640x480. Pediatric wide-field fundus photograph — 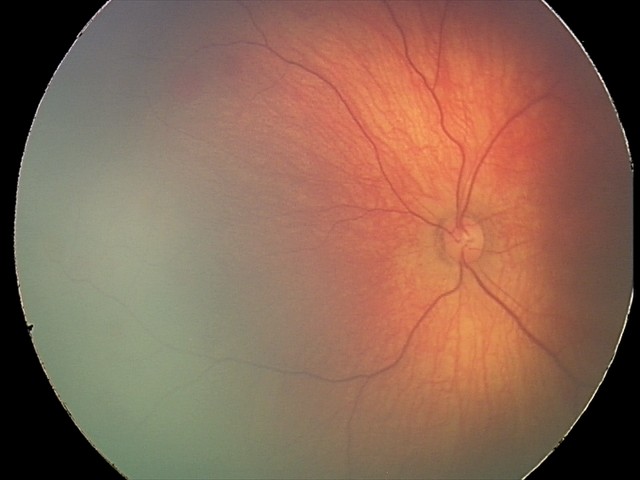
Series diagnosed as retinal hemorrhages.